Image size 640x480; wide-field fundus photograph of an infant
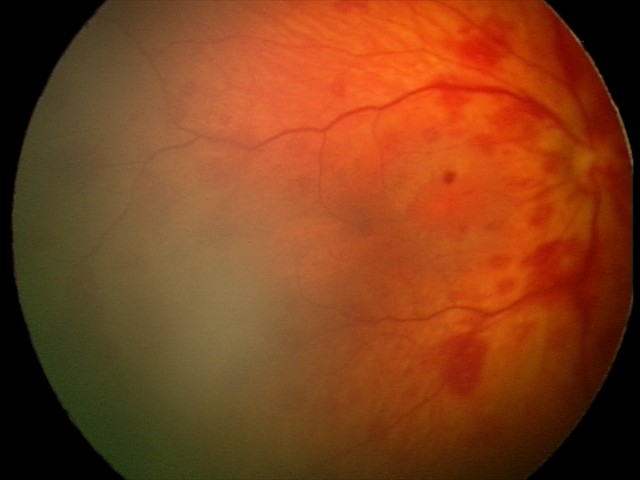
Finding: retinal hemorrhages.